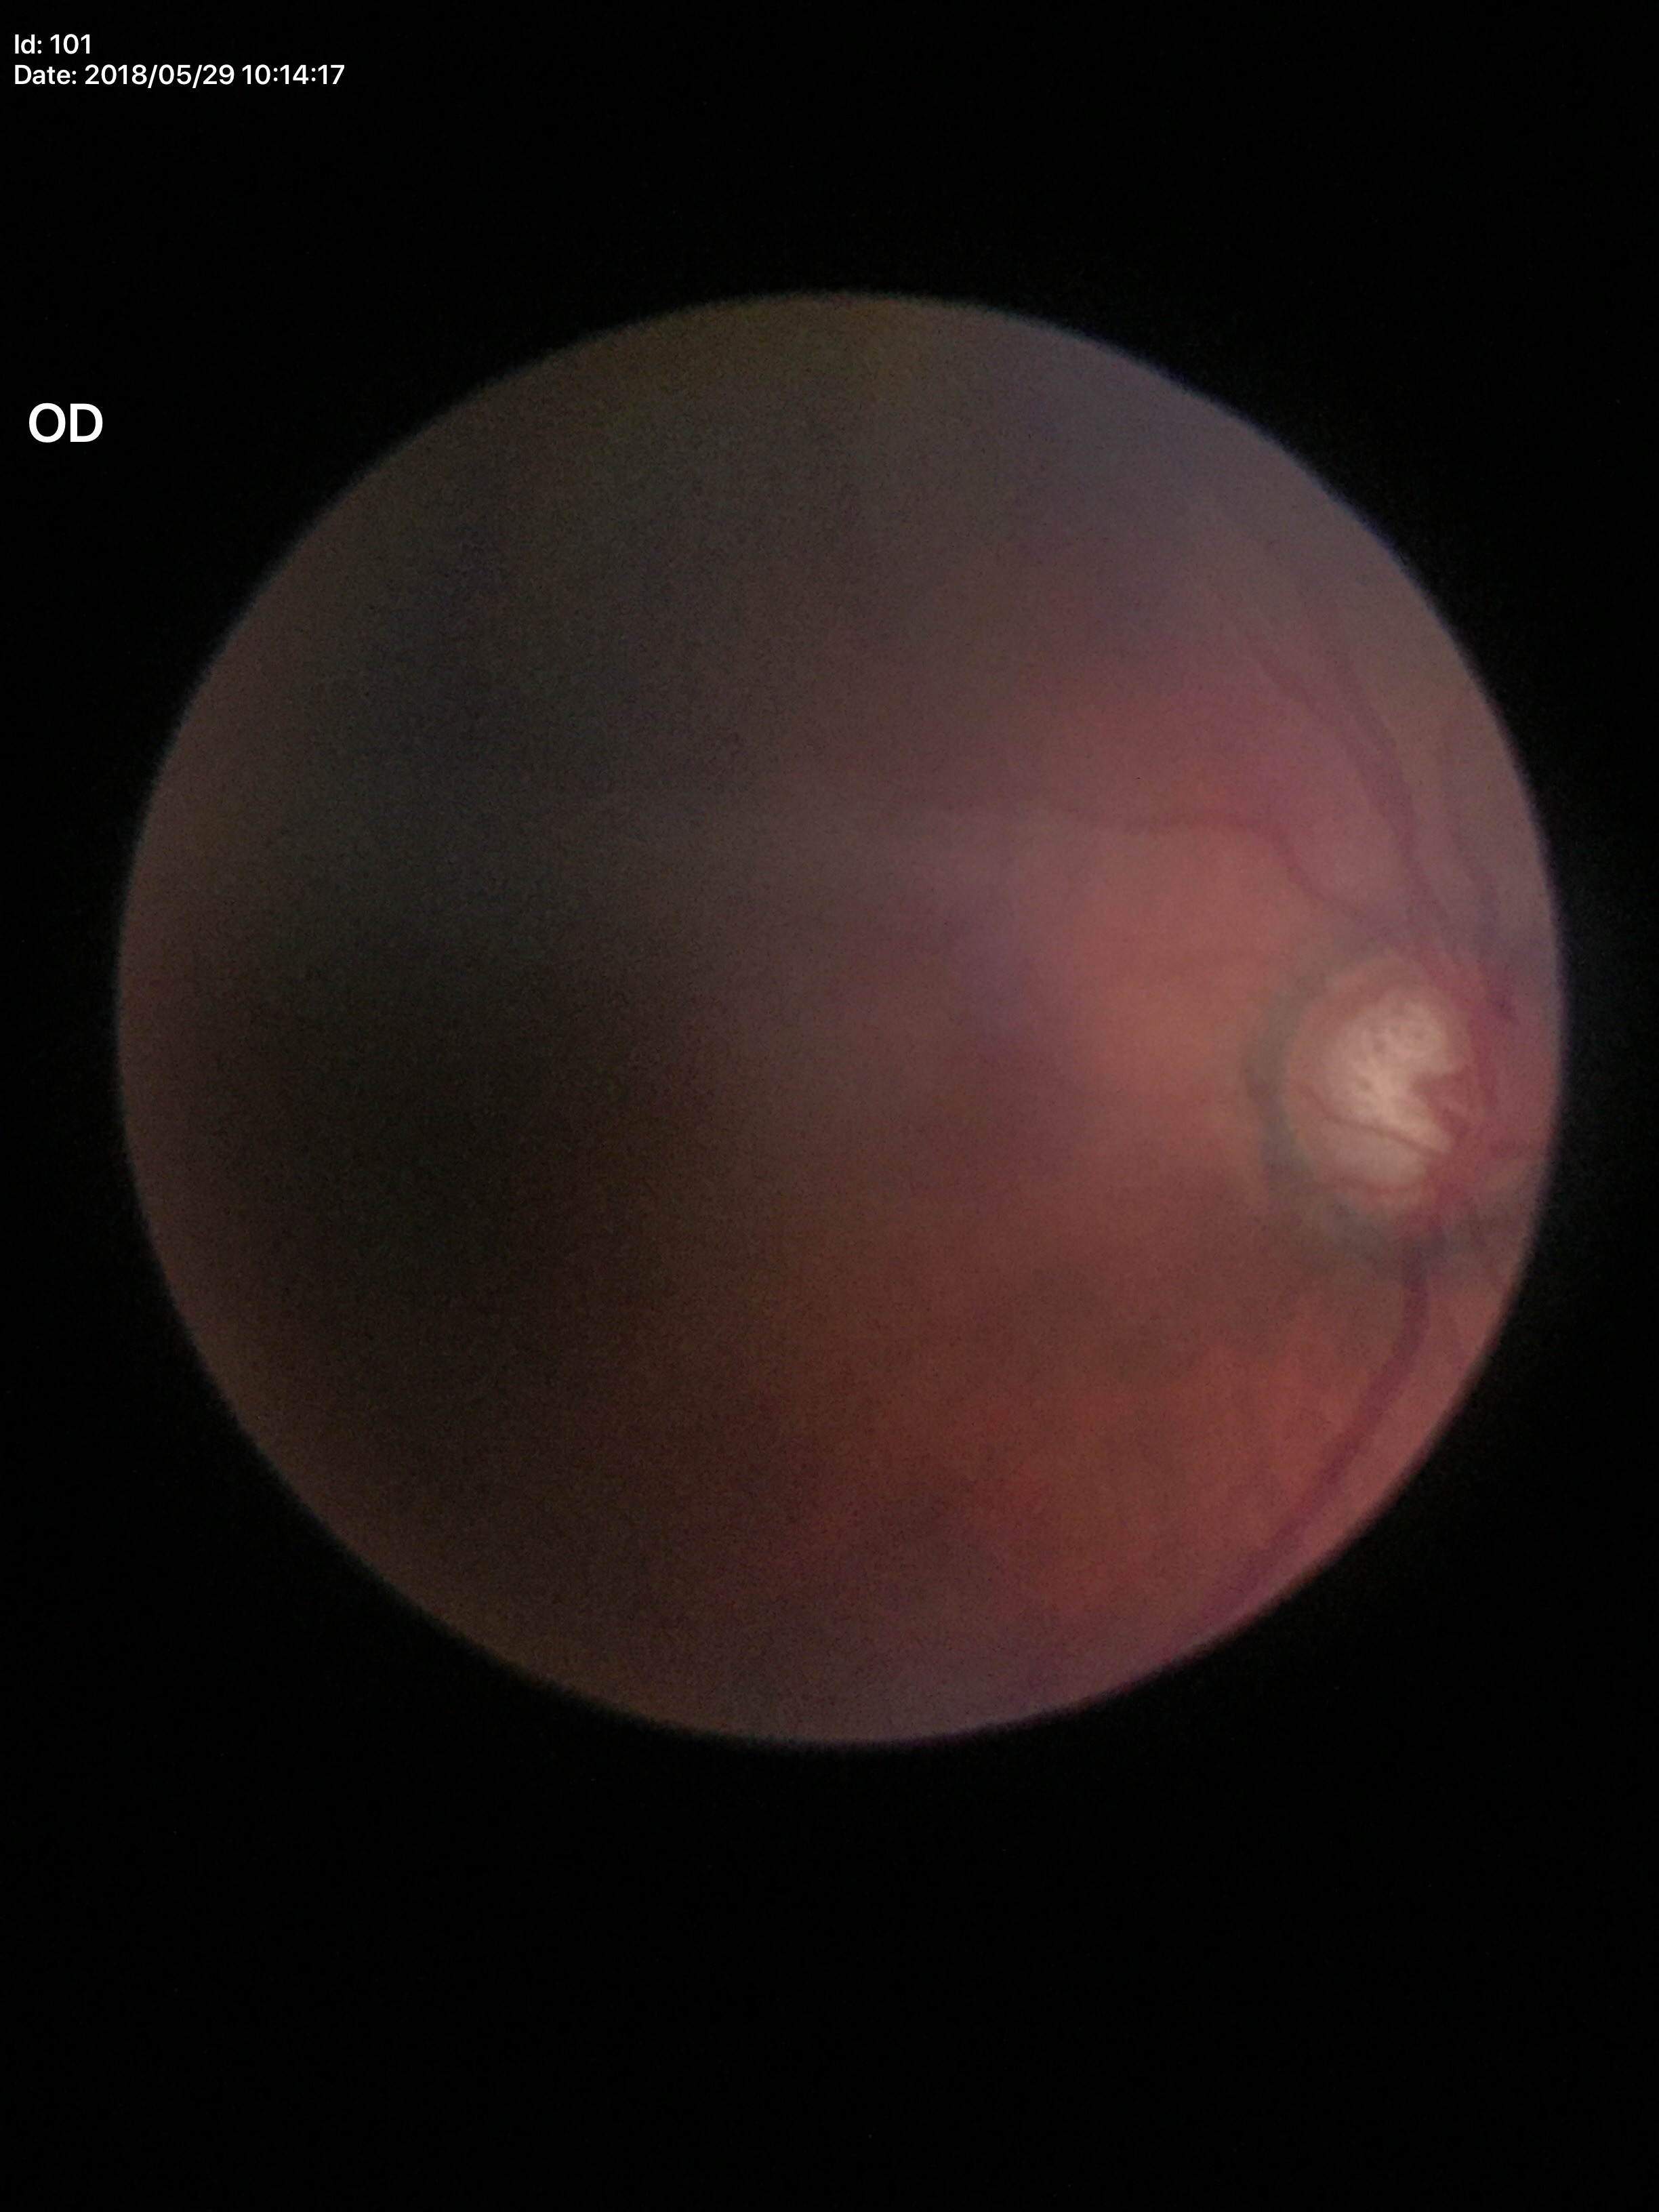

Glaucoma impression: suspicious; vertical cup-to-disc ratio (VCDR): 0.79; horizontal cup-disc ratio (HCDR): 0.70; area cup-to-disc ratio (ACDR): 0.53.